2048 by 1536 pixels.
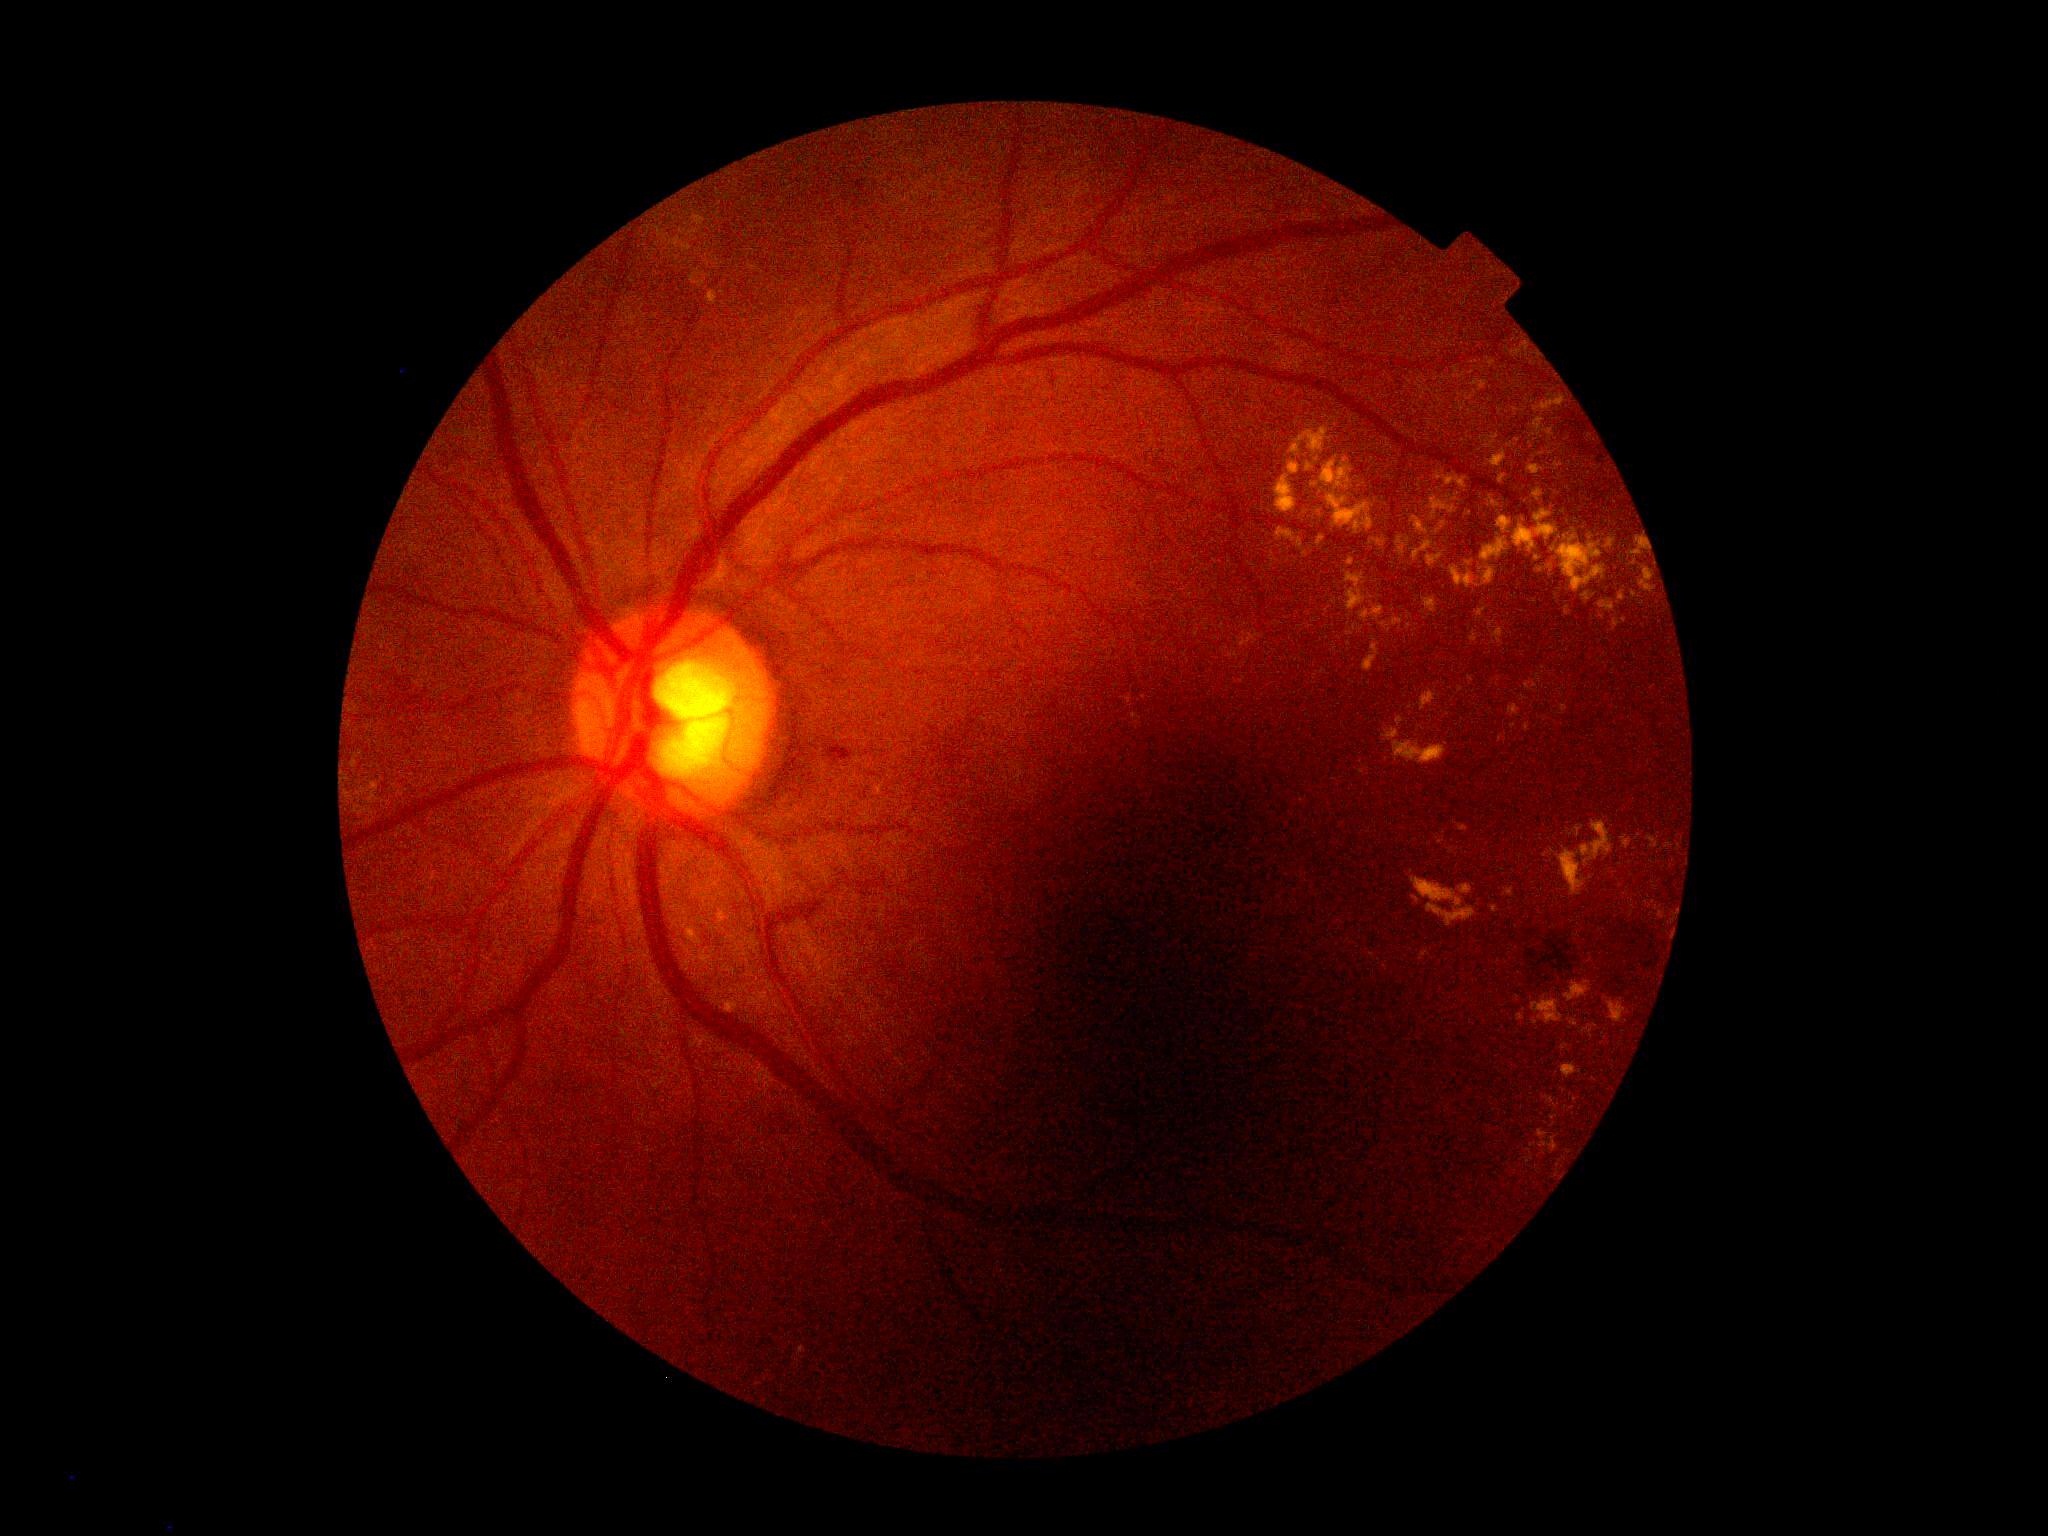 Retinopathy grade is 2.